1960 by 1897 pixels, color fundus photograph:
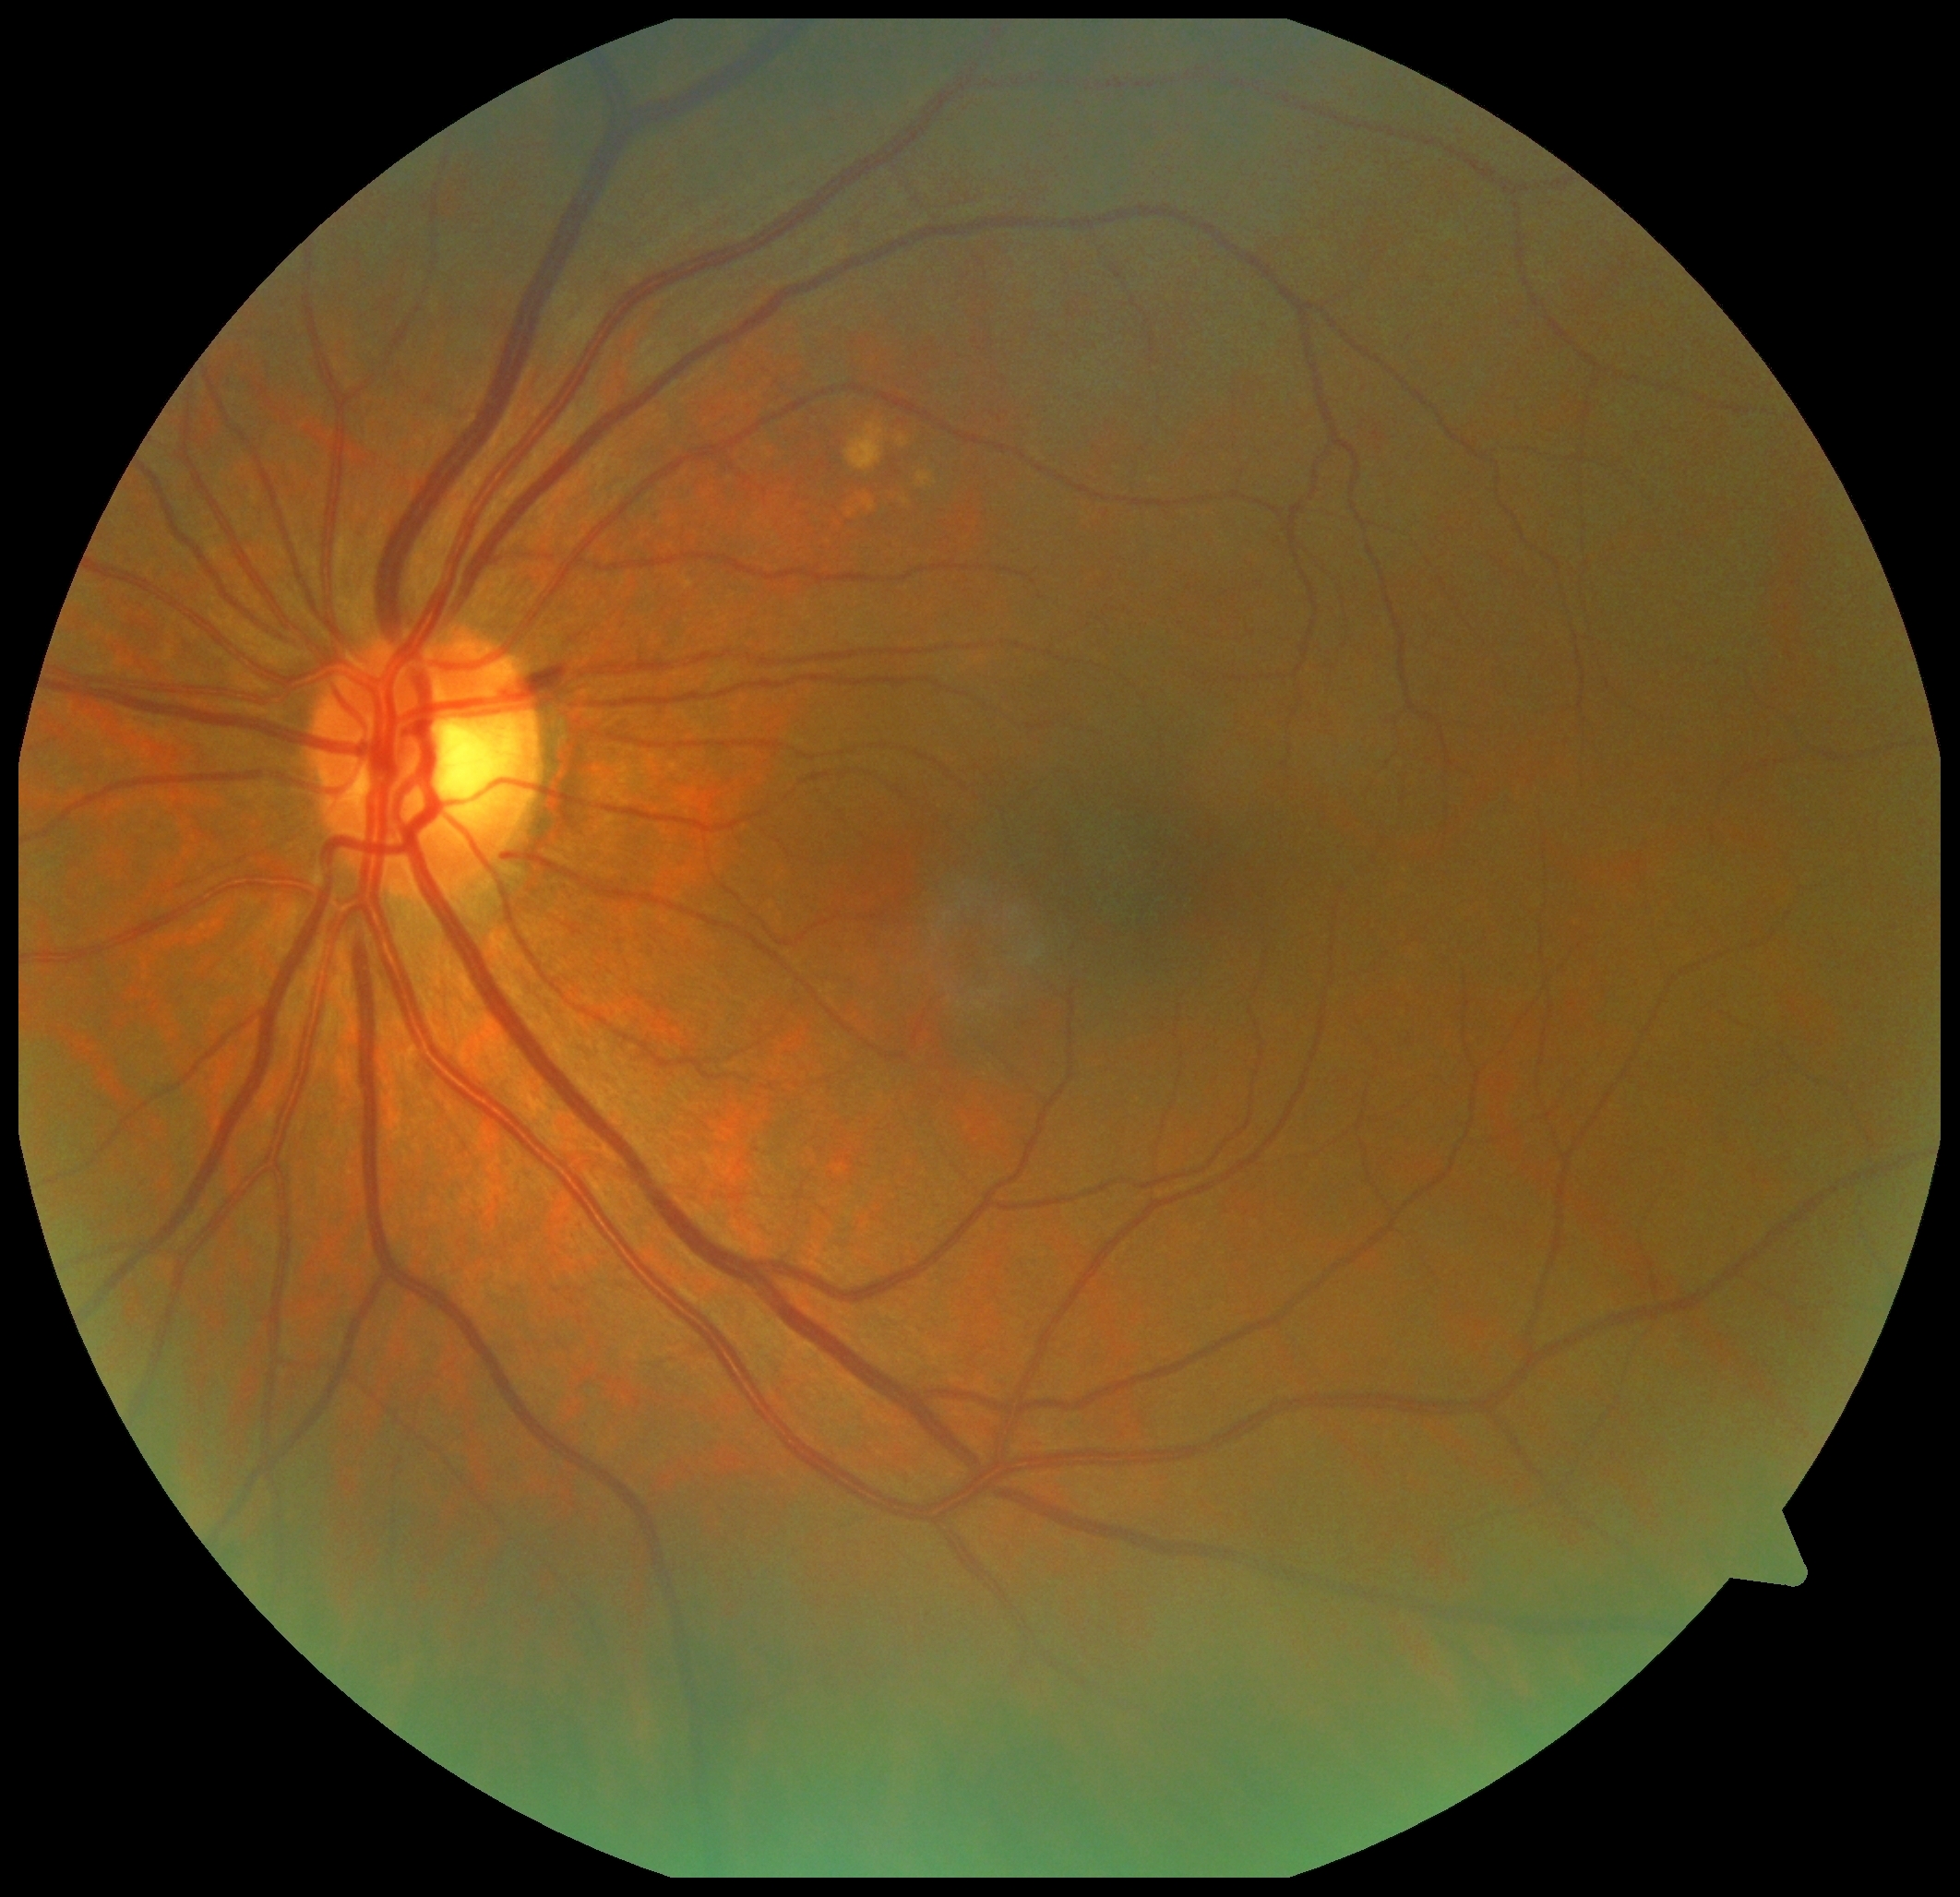 Retinopathy grade: 2 — more than just microaneurysms but less than severe NPDR.